FOV: 45 degrees; color fundus photograph: 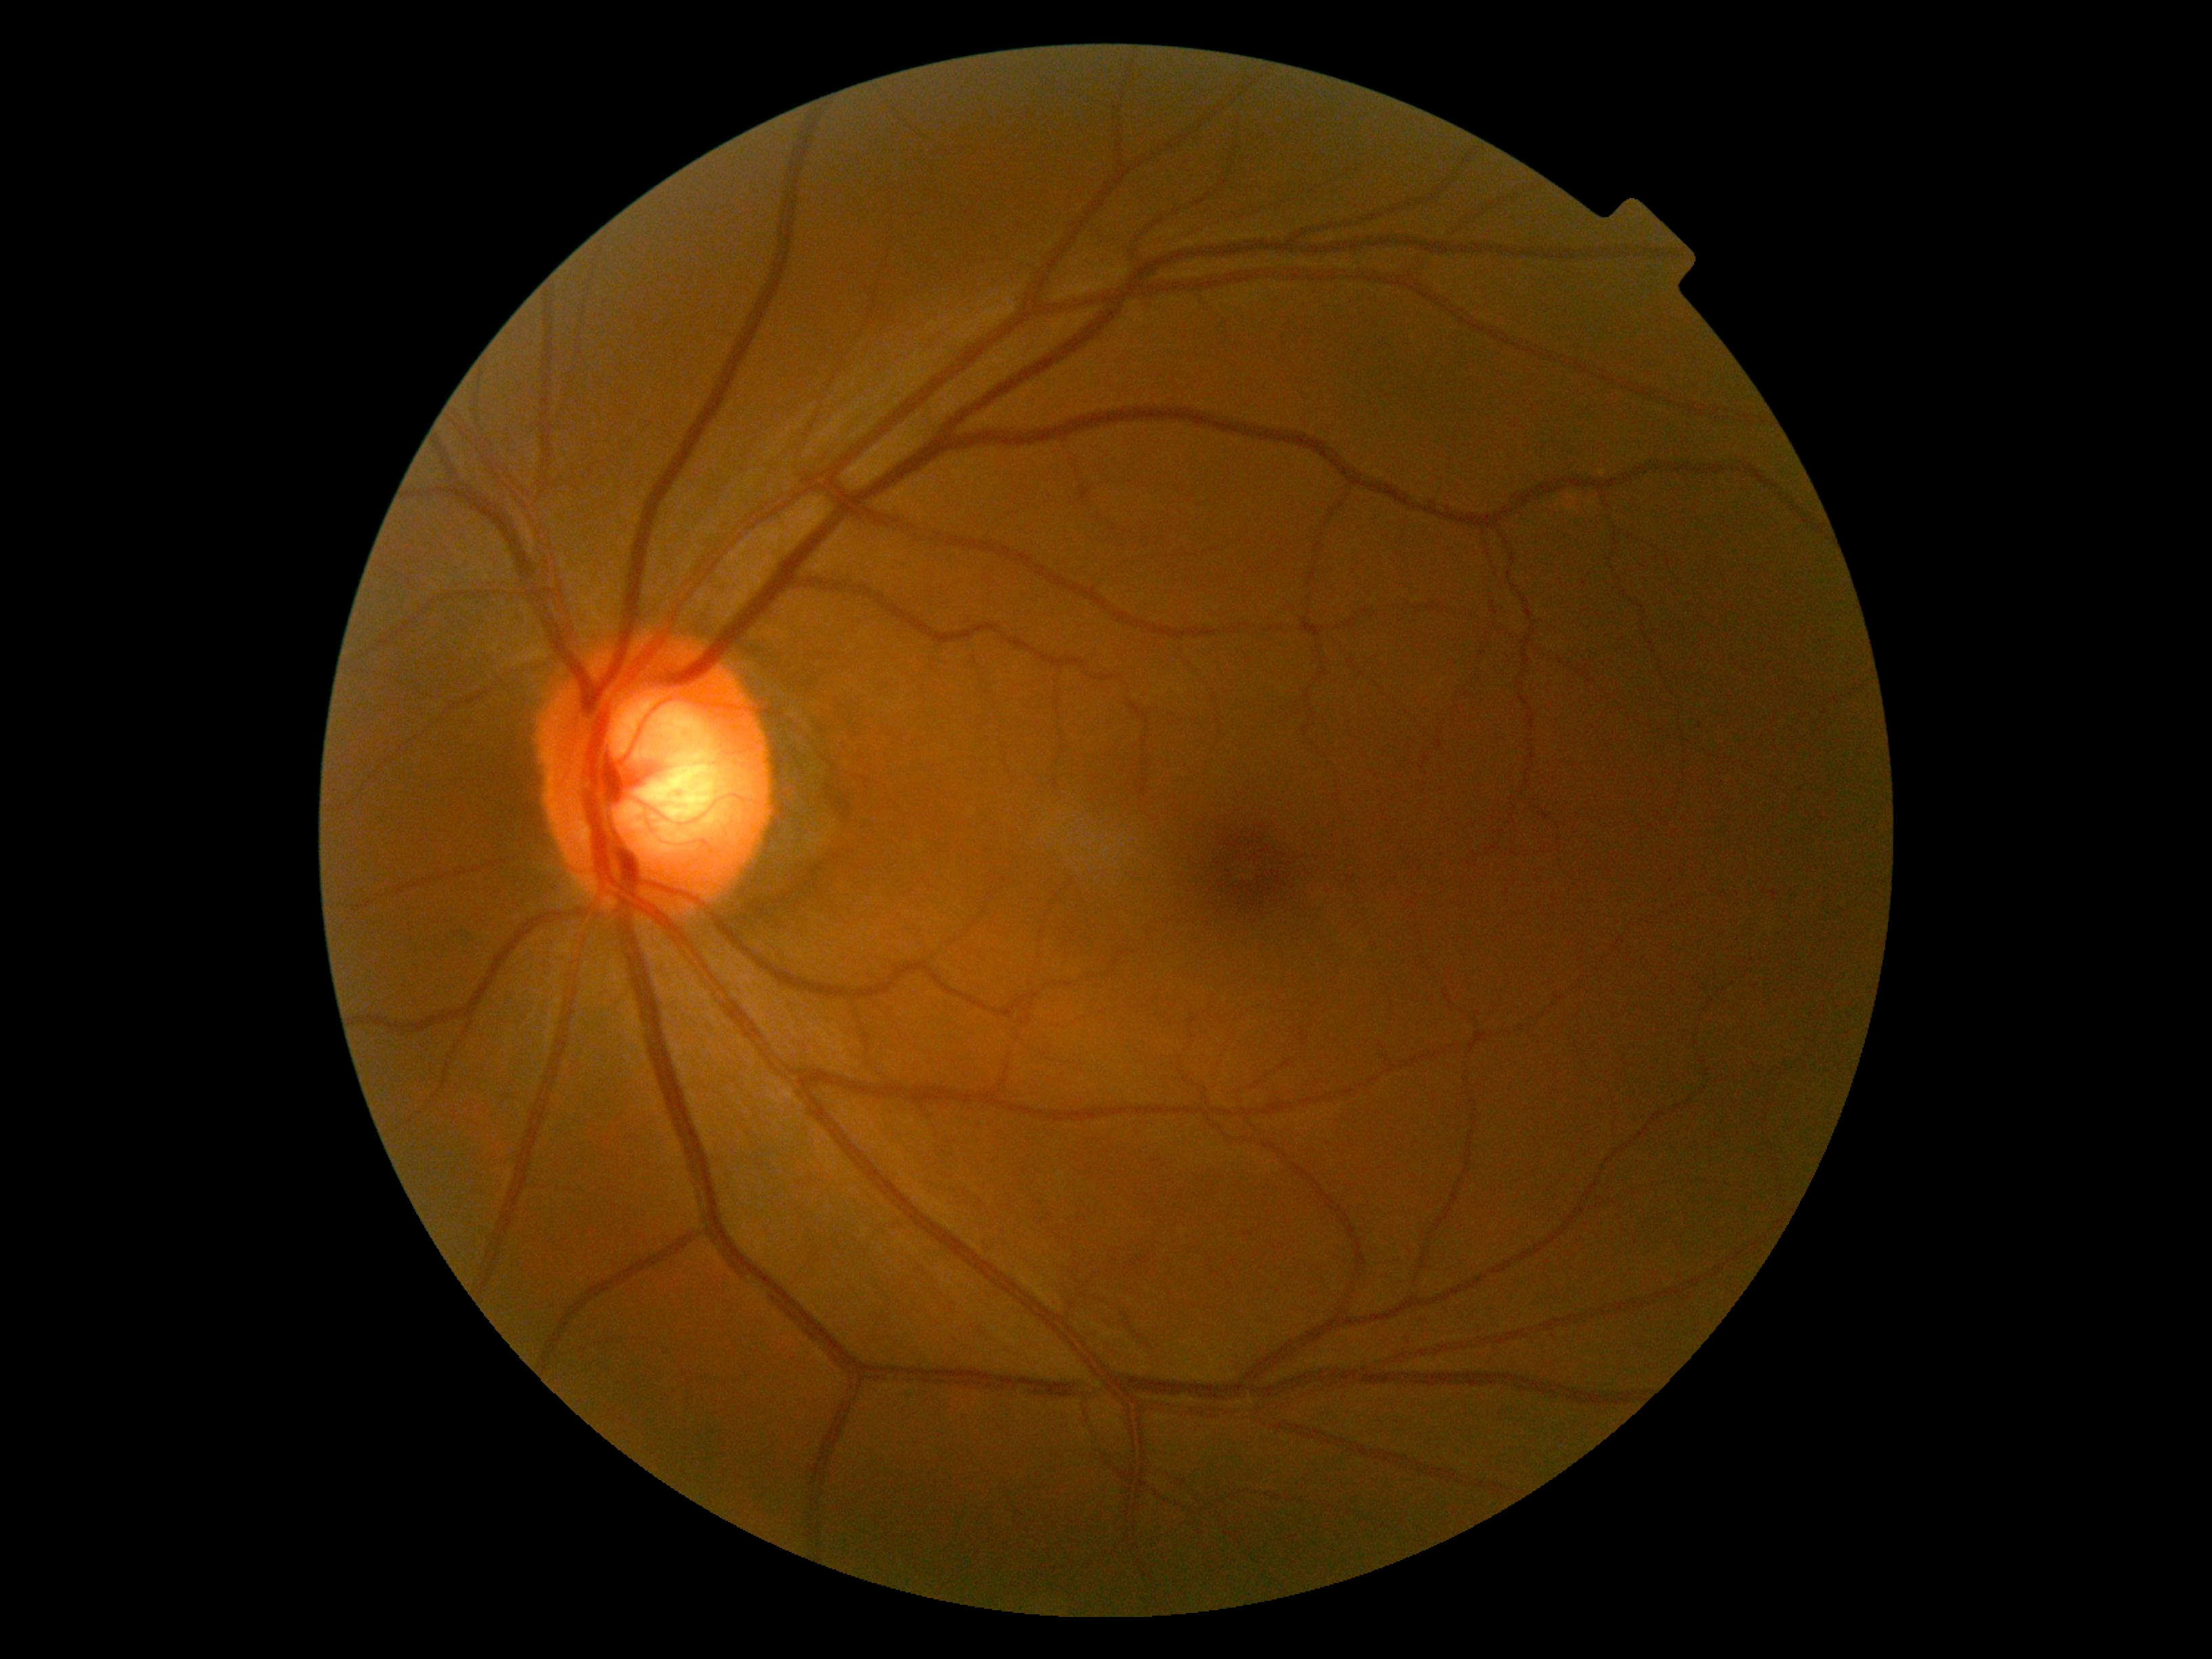
No signs of diabetic retinopathy. DR severity is no apparent diabetic retinopathy (grade 0).